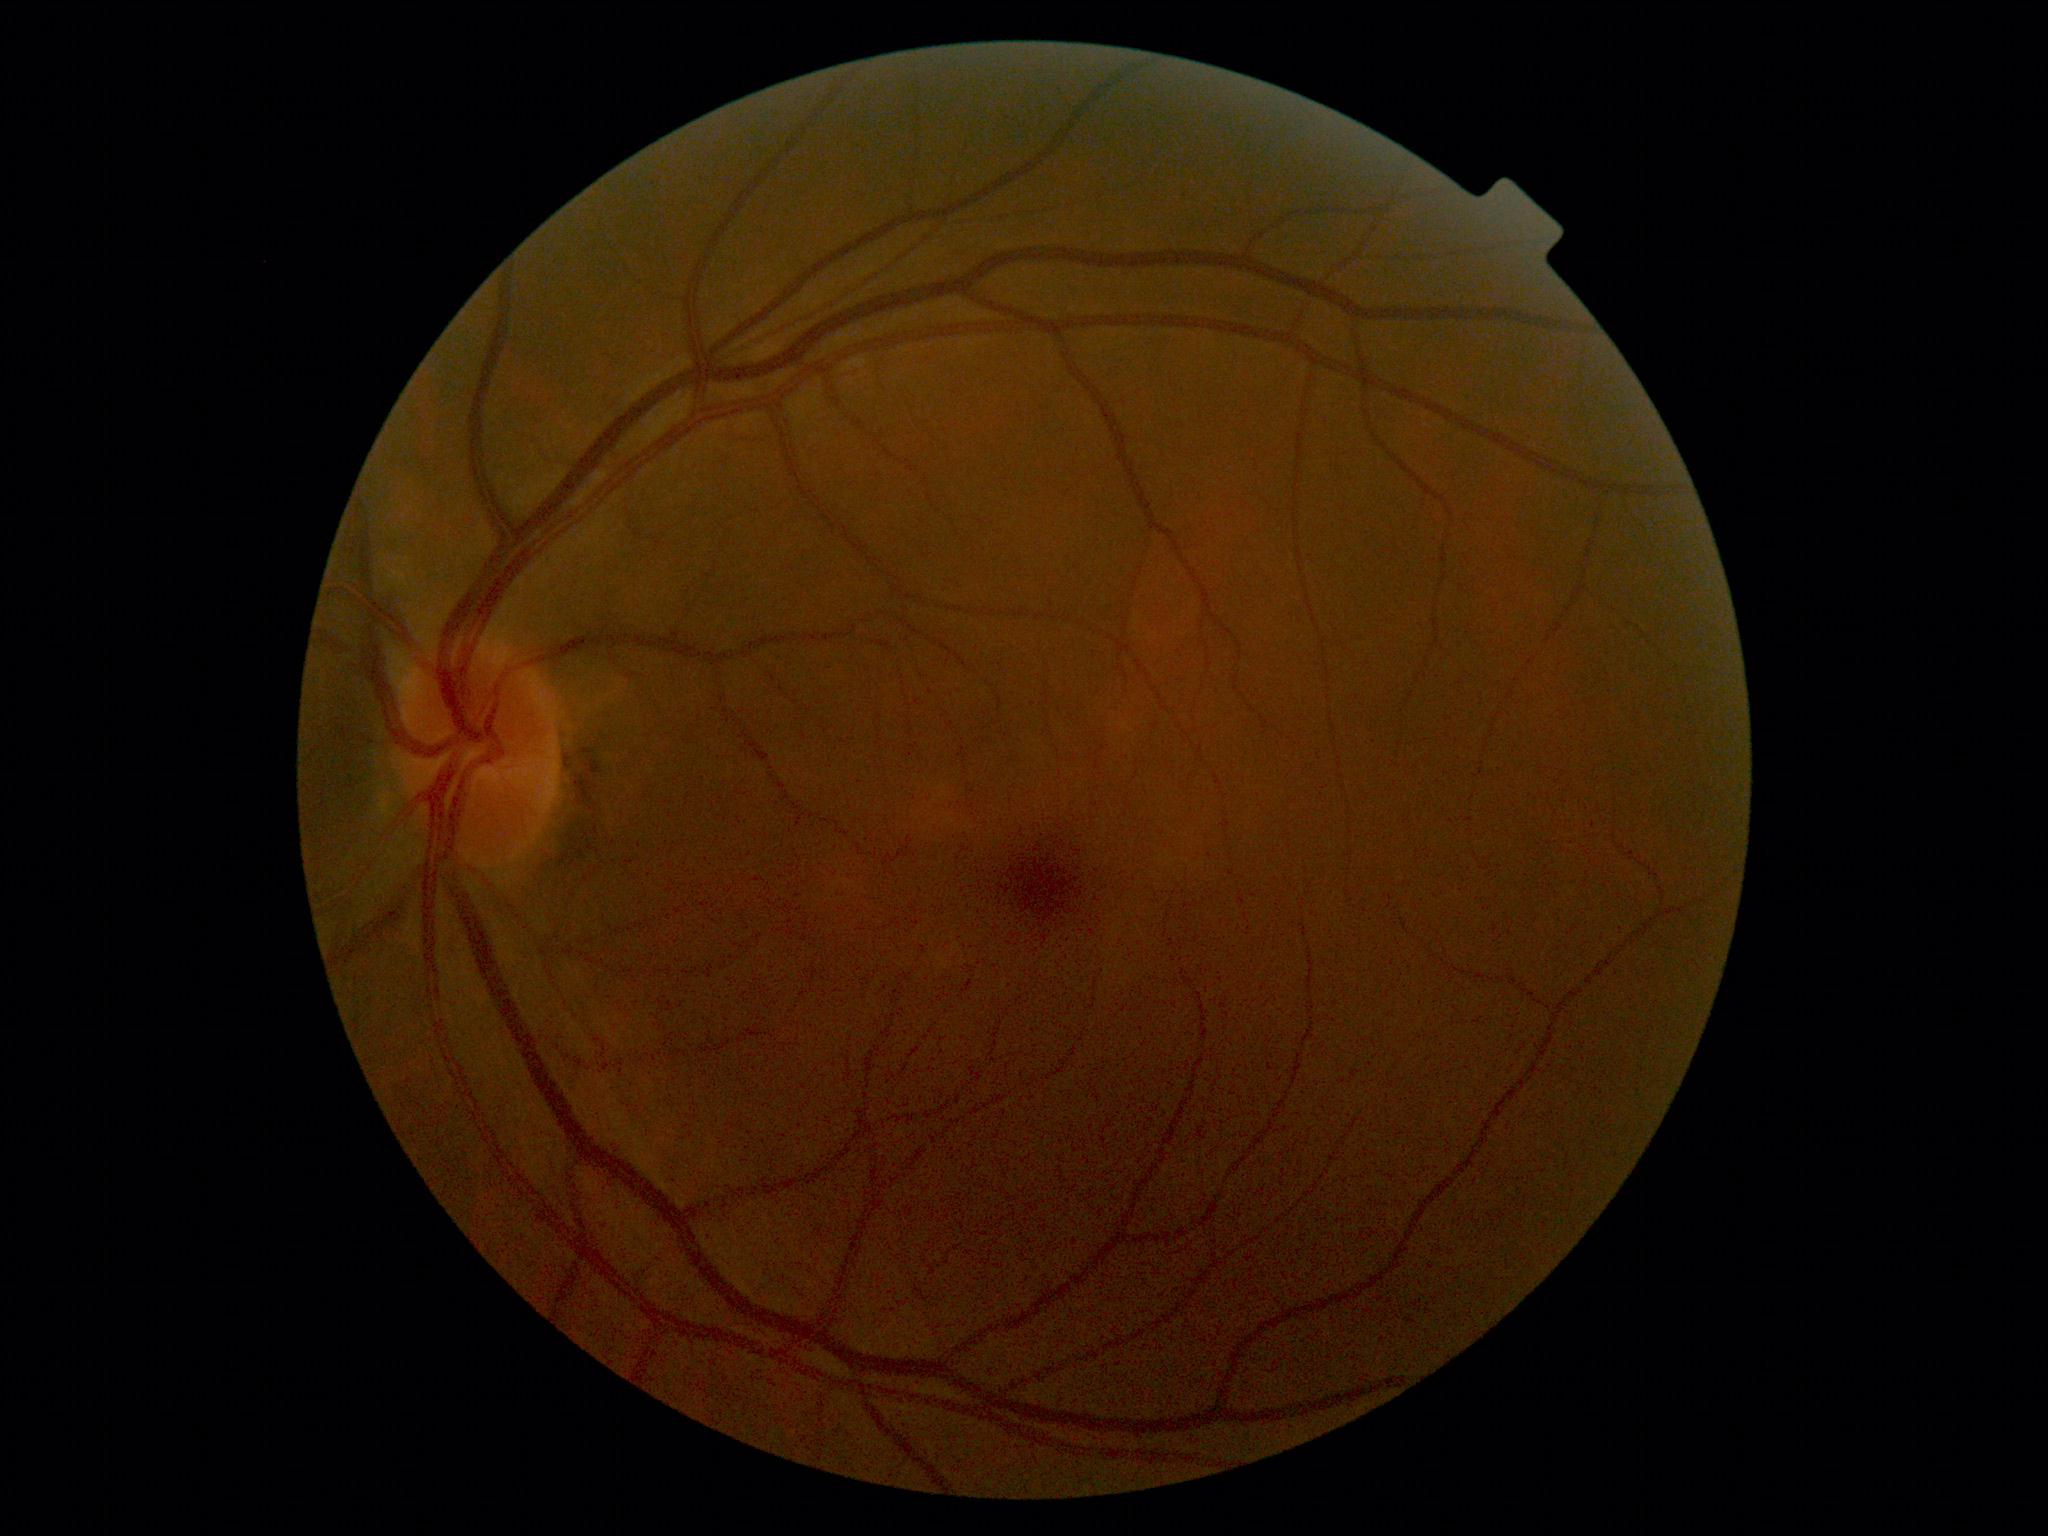 DR grade: 0.